FOV: 45 degrees · fundus photo.
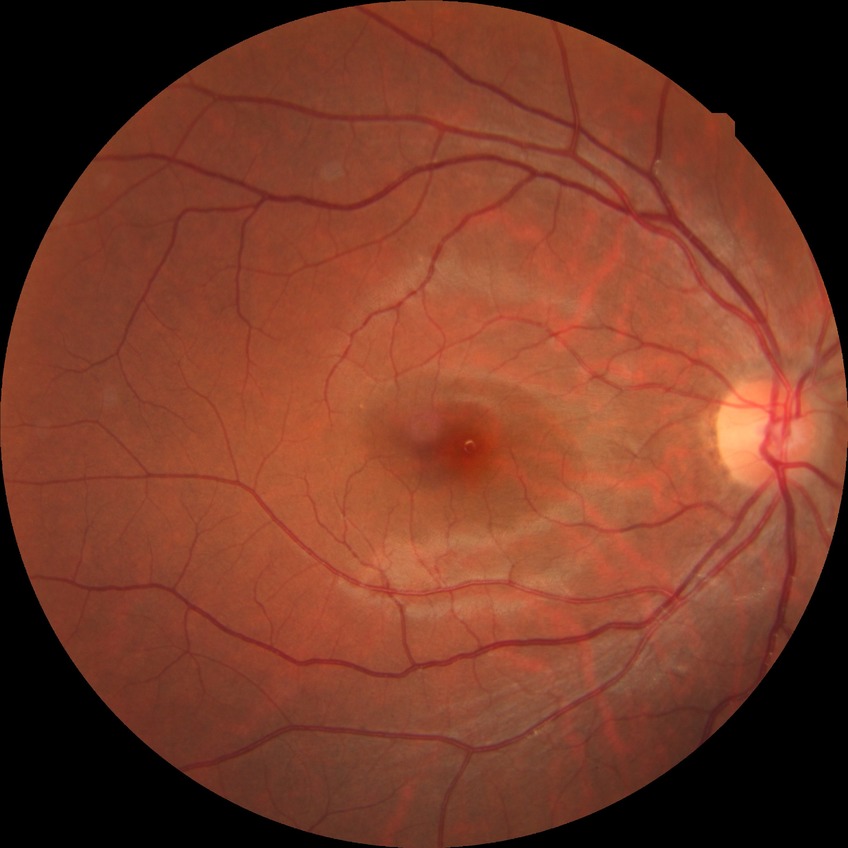 Diabetic retinopathy (DR) is no diabetic retinopathy (NDR).